45 degree fundus photograph · modified Davis grading · no pharmacologic dilation.
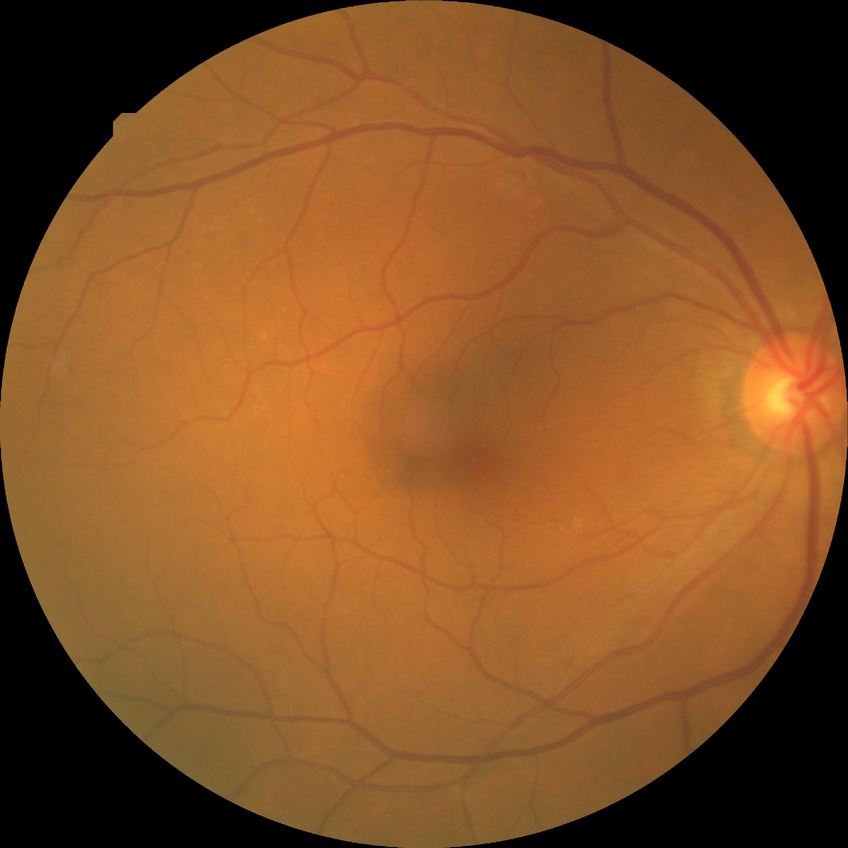 Retinopathy grade is no diabetic retinopathy.